848x848px; nonmydriatic fundus photograph:
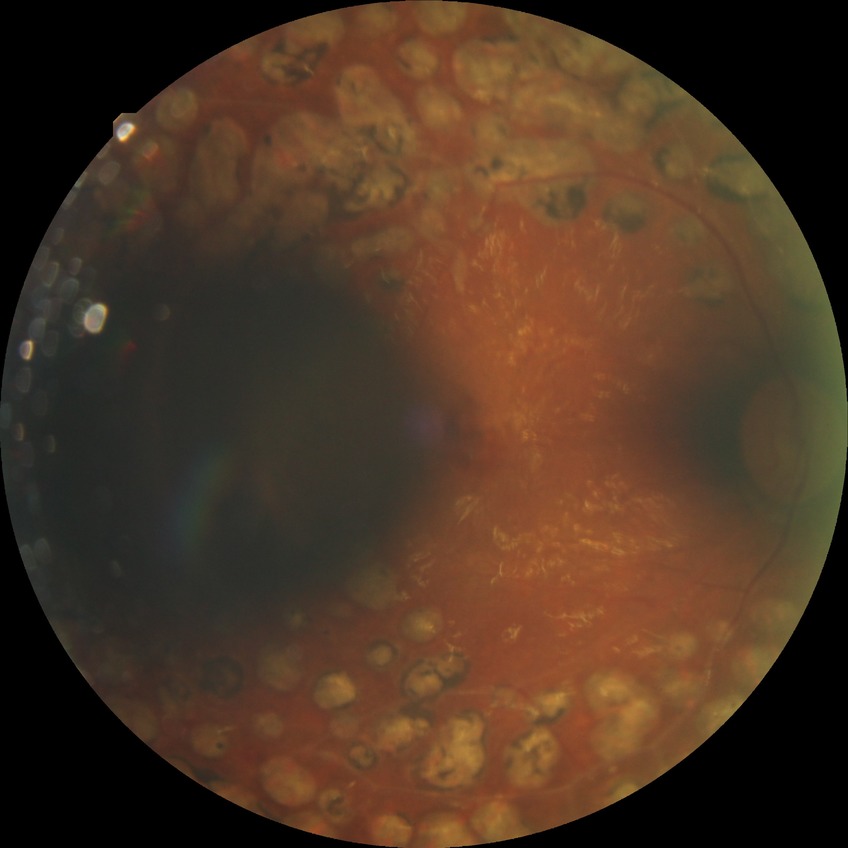
DR: PDR.